FOV: 45 degrees, 2350 by 1568 pixels, CFP — 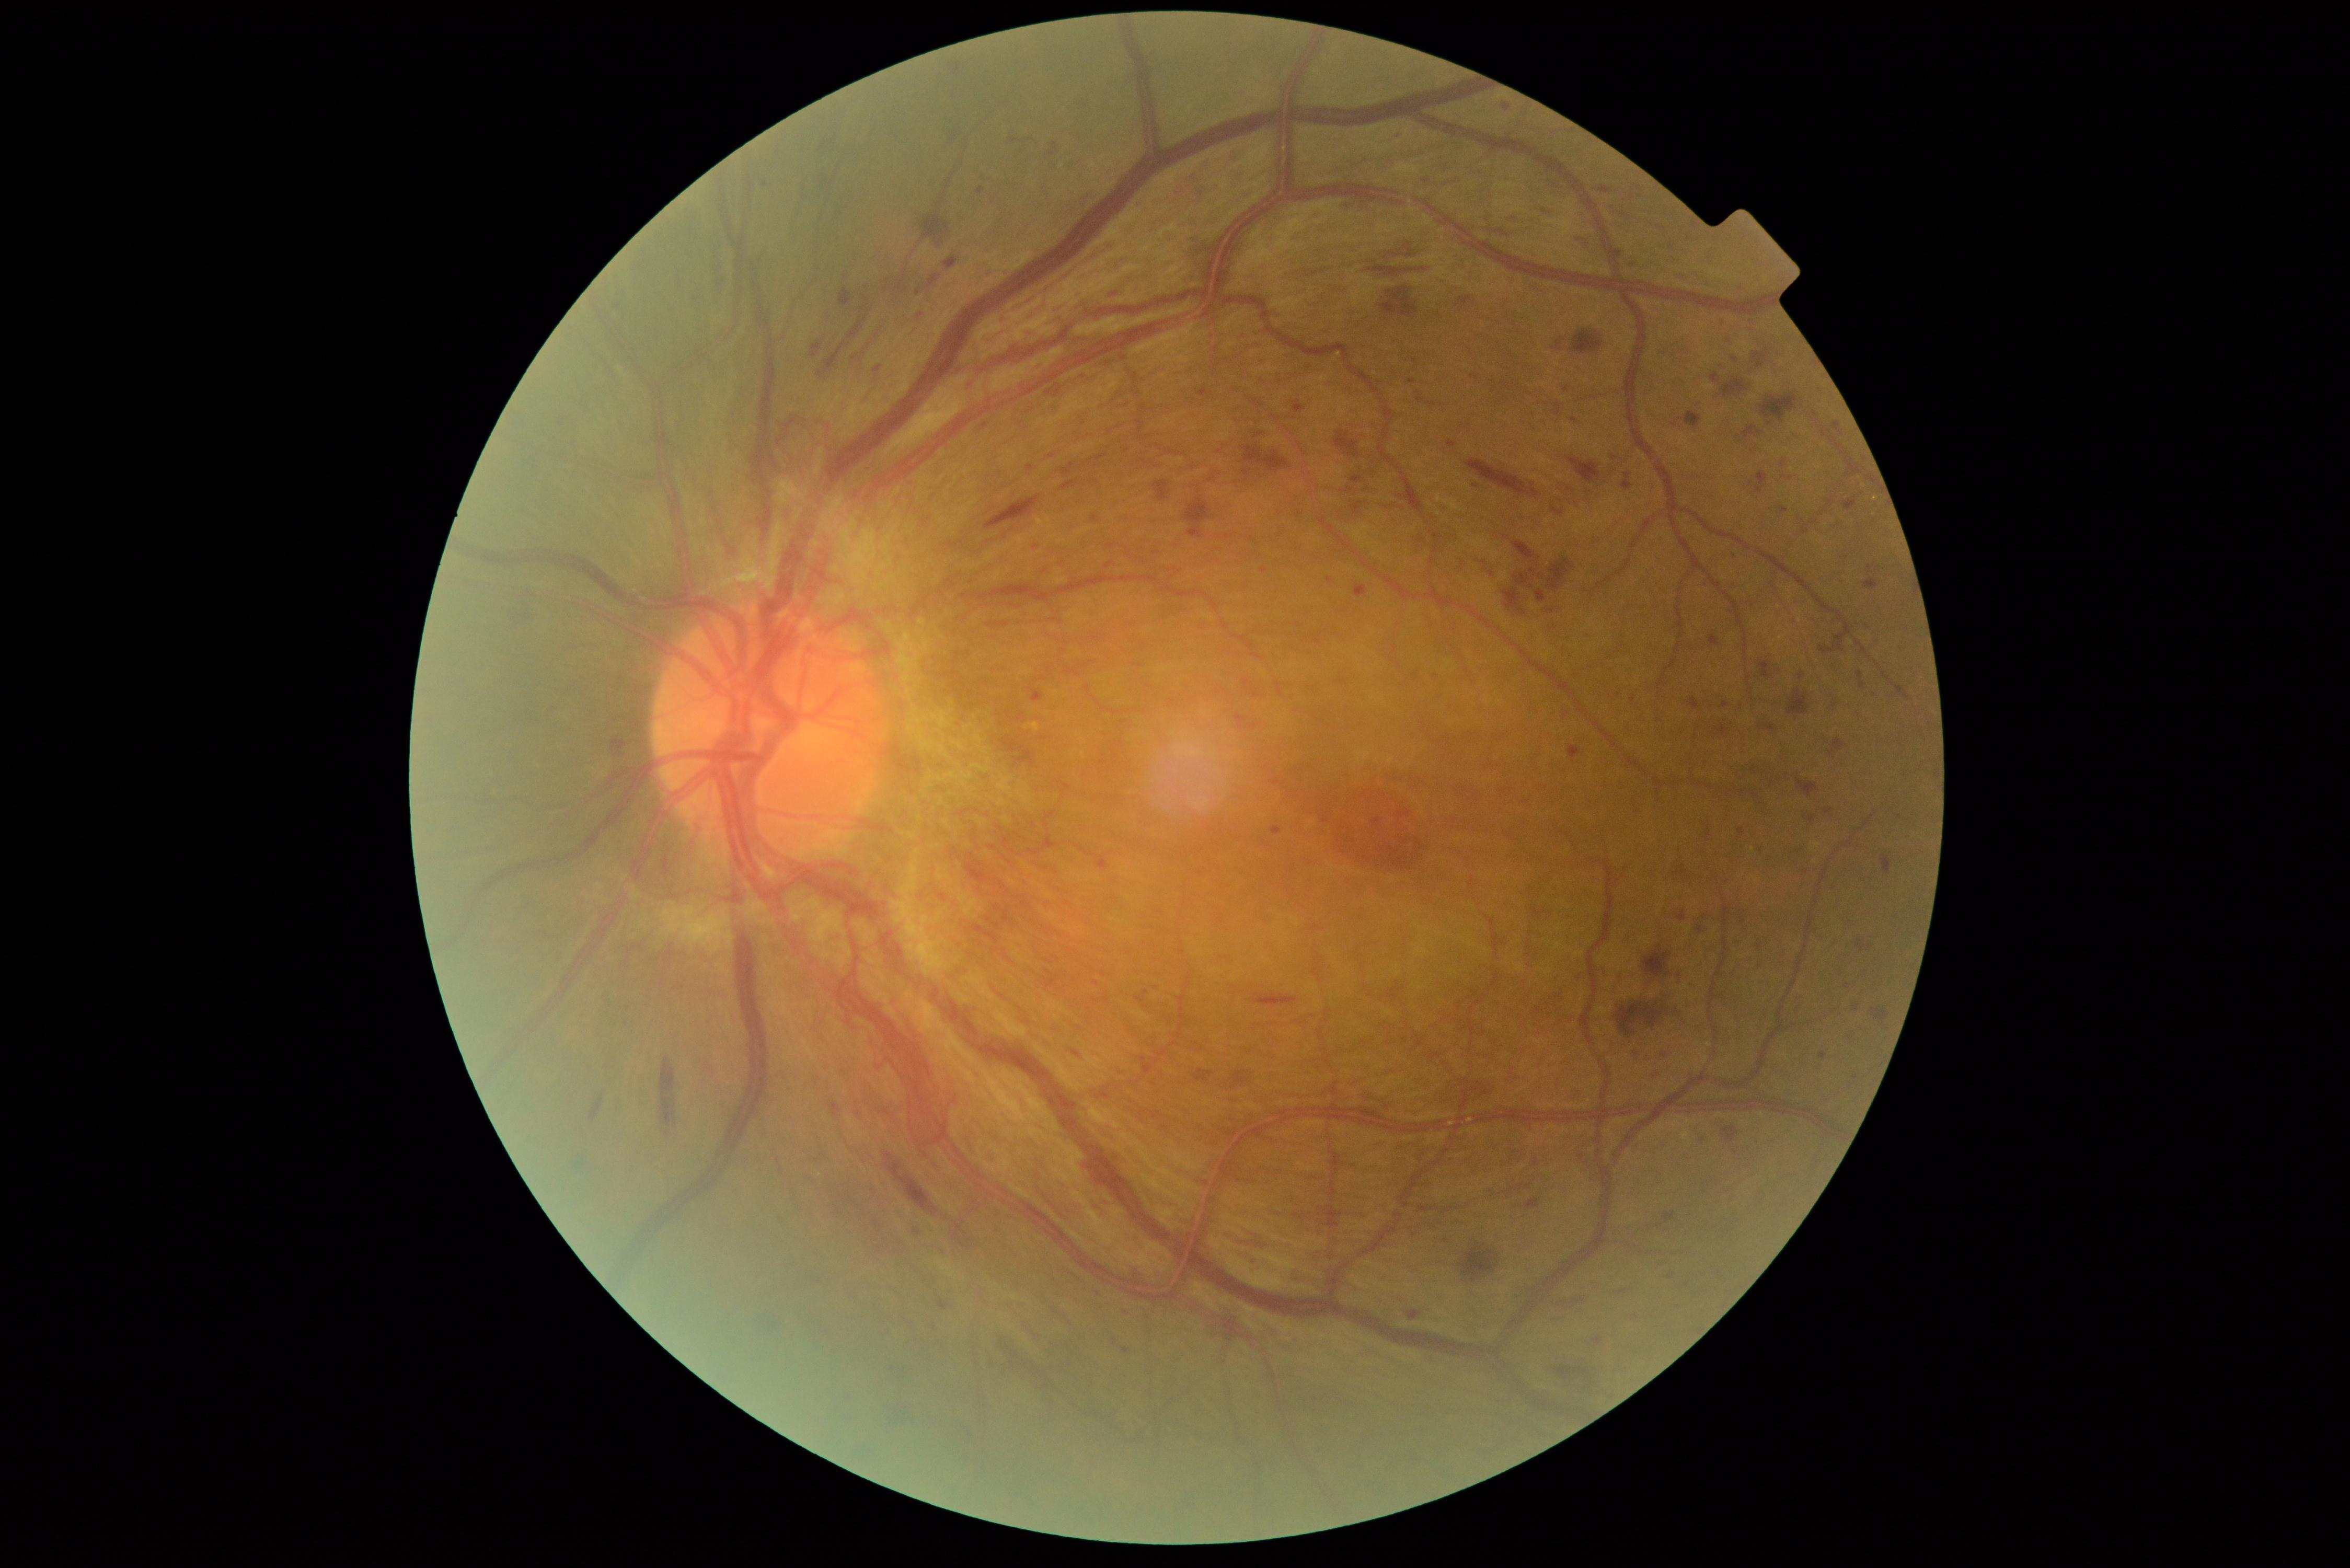
DR severity is PDR (grade 4); proliferative diabetic retinopathy
Selected lesions:
MAs (partial): 1868, 565, 1875, 573 | 1354, 586, 1368, 597 | 1825, 810, 1833, 814 | 1710, 373, 1721, 383 | 1199, 388, 1207, 397 | 1710, 635, 1719, 645 | 1470, 375, 1478, 379 | 1615, 251, 1623, 262 | 1819, 1053, 1828, 1058
Additional small MAs near (1412, 382) | (1801, 1011) | (1626, 473) | (1618, 695) | (1847, 986) | (1326, 821) | (618, 307) | (1729, 340)
HEs (partial): 848, 321, 862, 339 | 1832, 422, 1844, 435 | 1619, 1312, 1637, 1320 | 1334, 431, 1361, 458 | 1599, 187, 1612, 194 | 1478, 1086, 1492, 1099 | 1832, 739, 1846, 751 | 786, 418, 797, 430 | 928, 275, 941, 289 | 1096, 454, 1107, 462 | 1465, 459, 1539, 497 | 811, 342, 824, 358 | 1028, 837, 1057, 857 | 1389, 242, 1419, 258 | 942, 124, 956, 151 | 1643, 944, 1673, 978 | 1554, 1298, 1587, 1306 | 1461, 1247, 1499, 1282 | 1105, 291, 1116, 296
Additional small HEs near (1013, 141)